Macula-centered field — 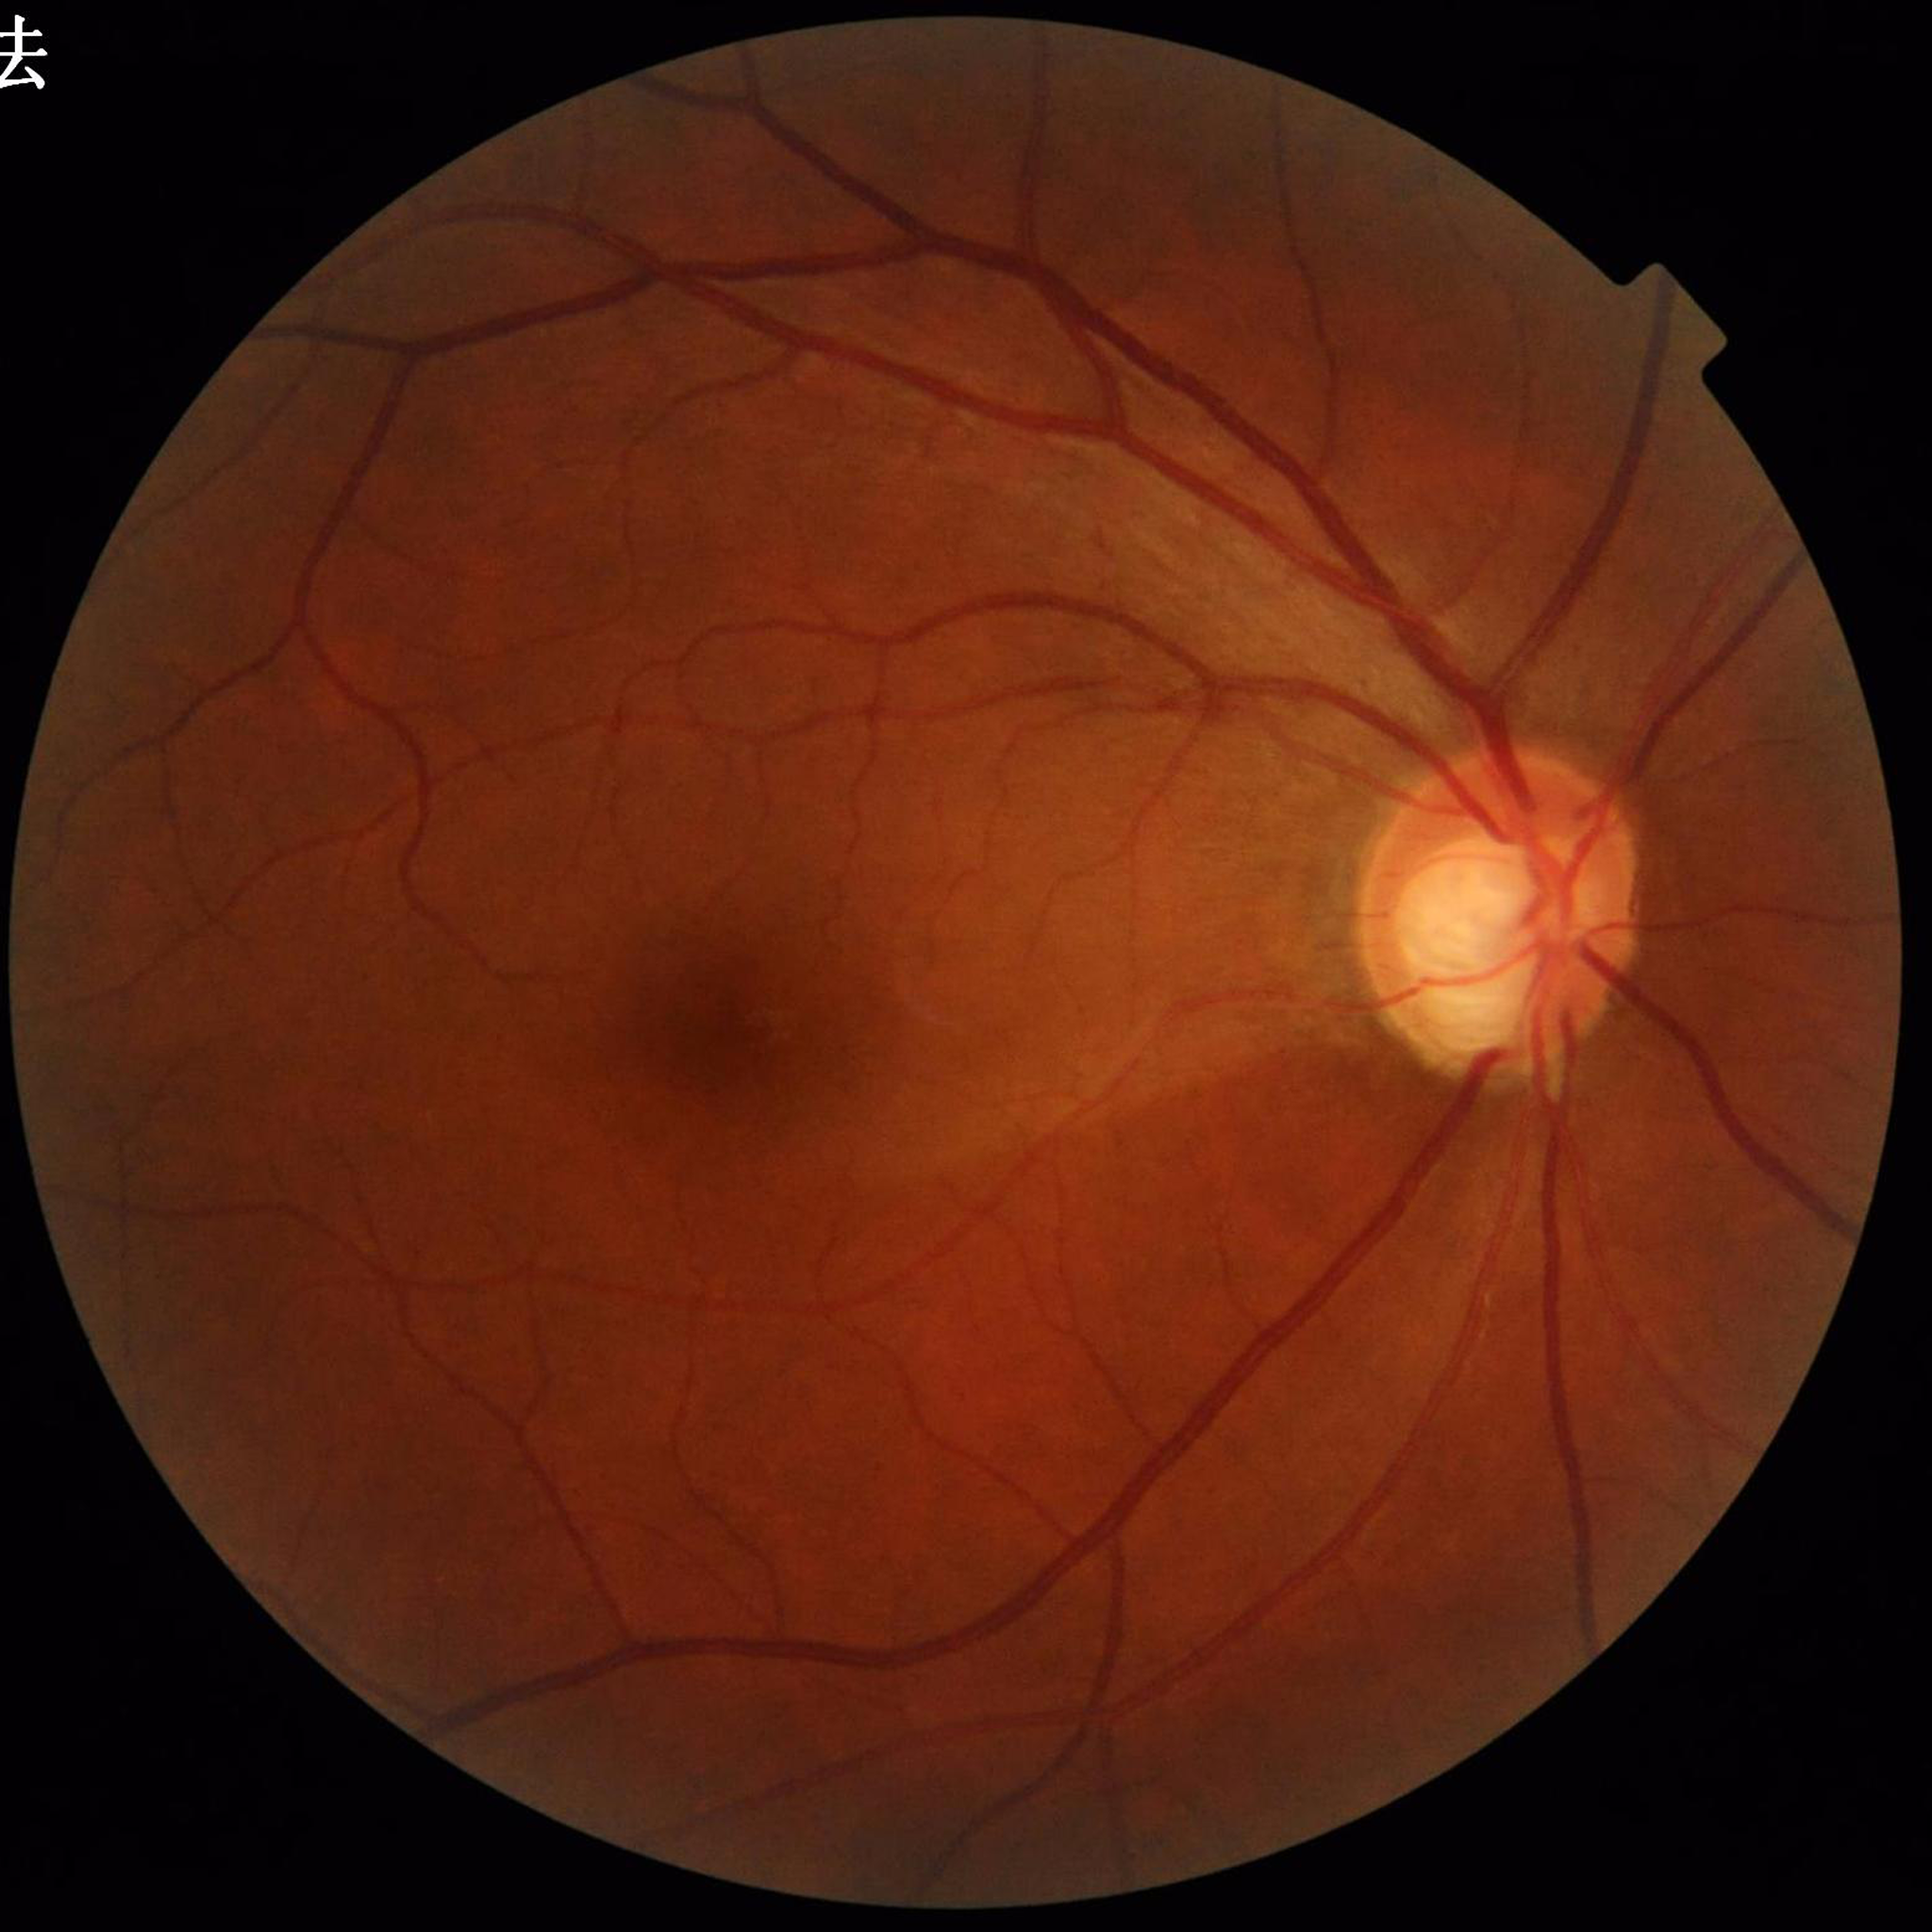

Quality: no quality issues identified; Clinical diagnosis: glaucoma.